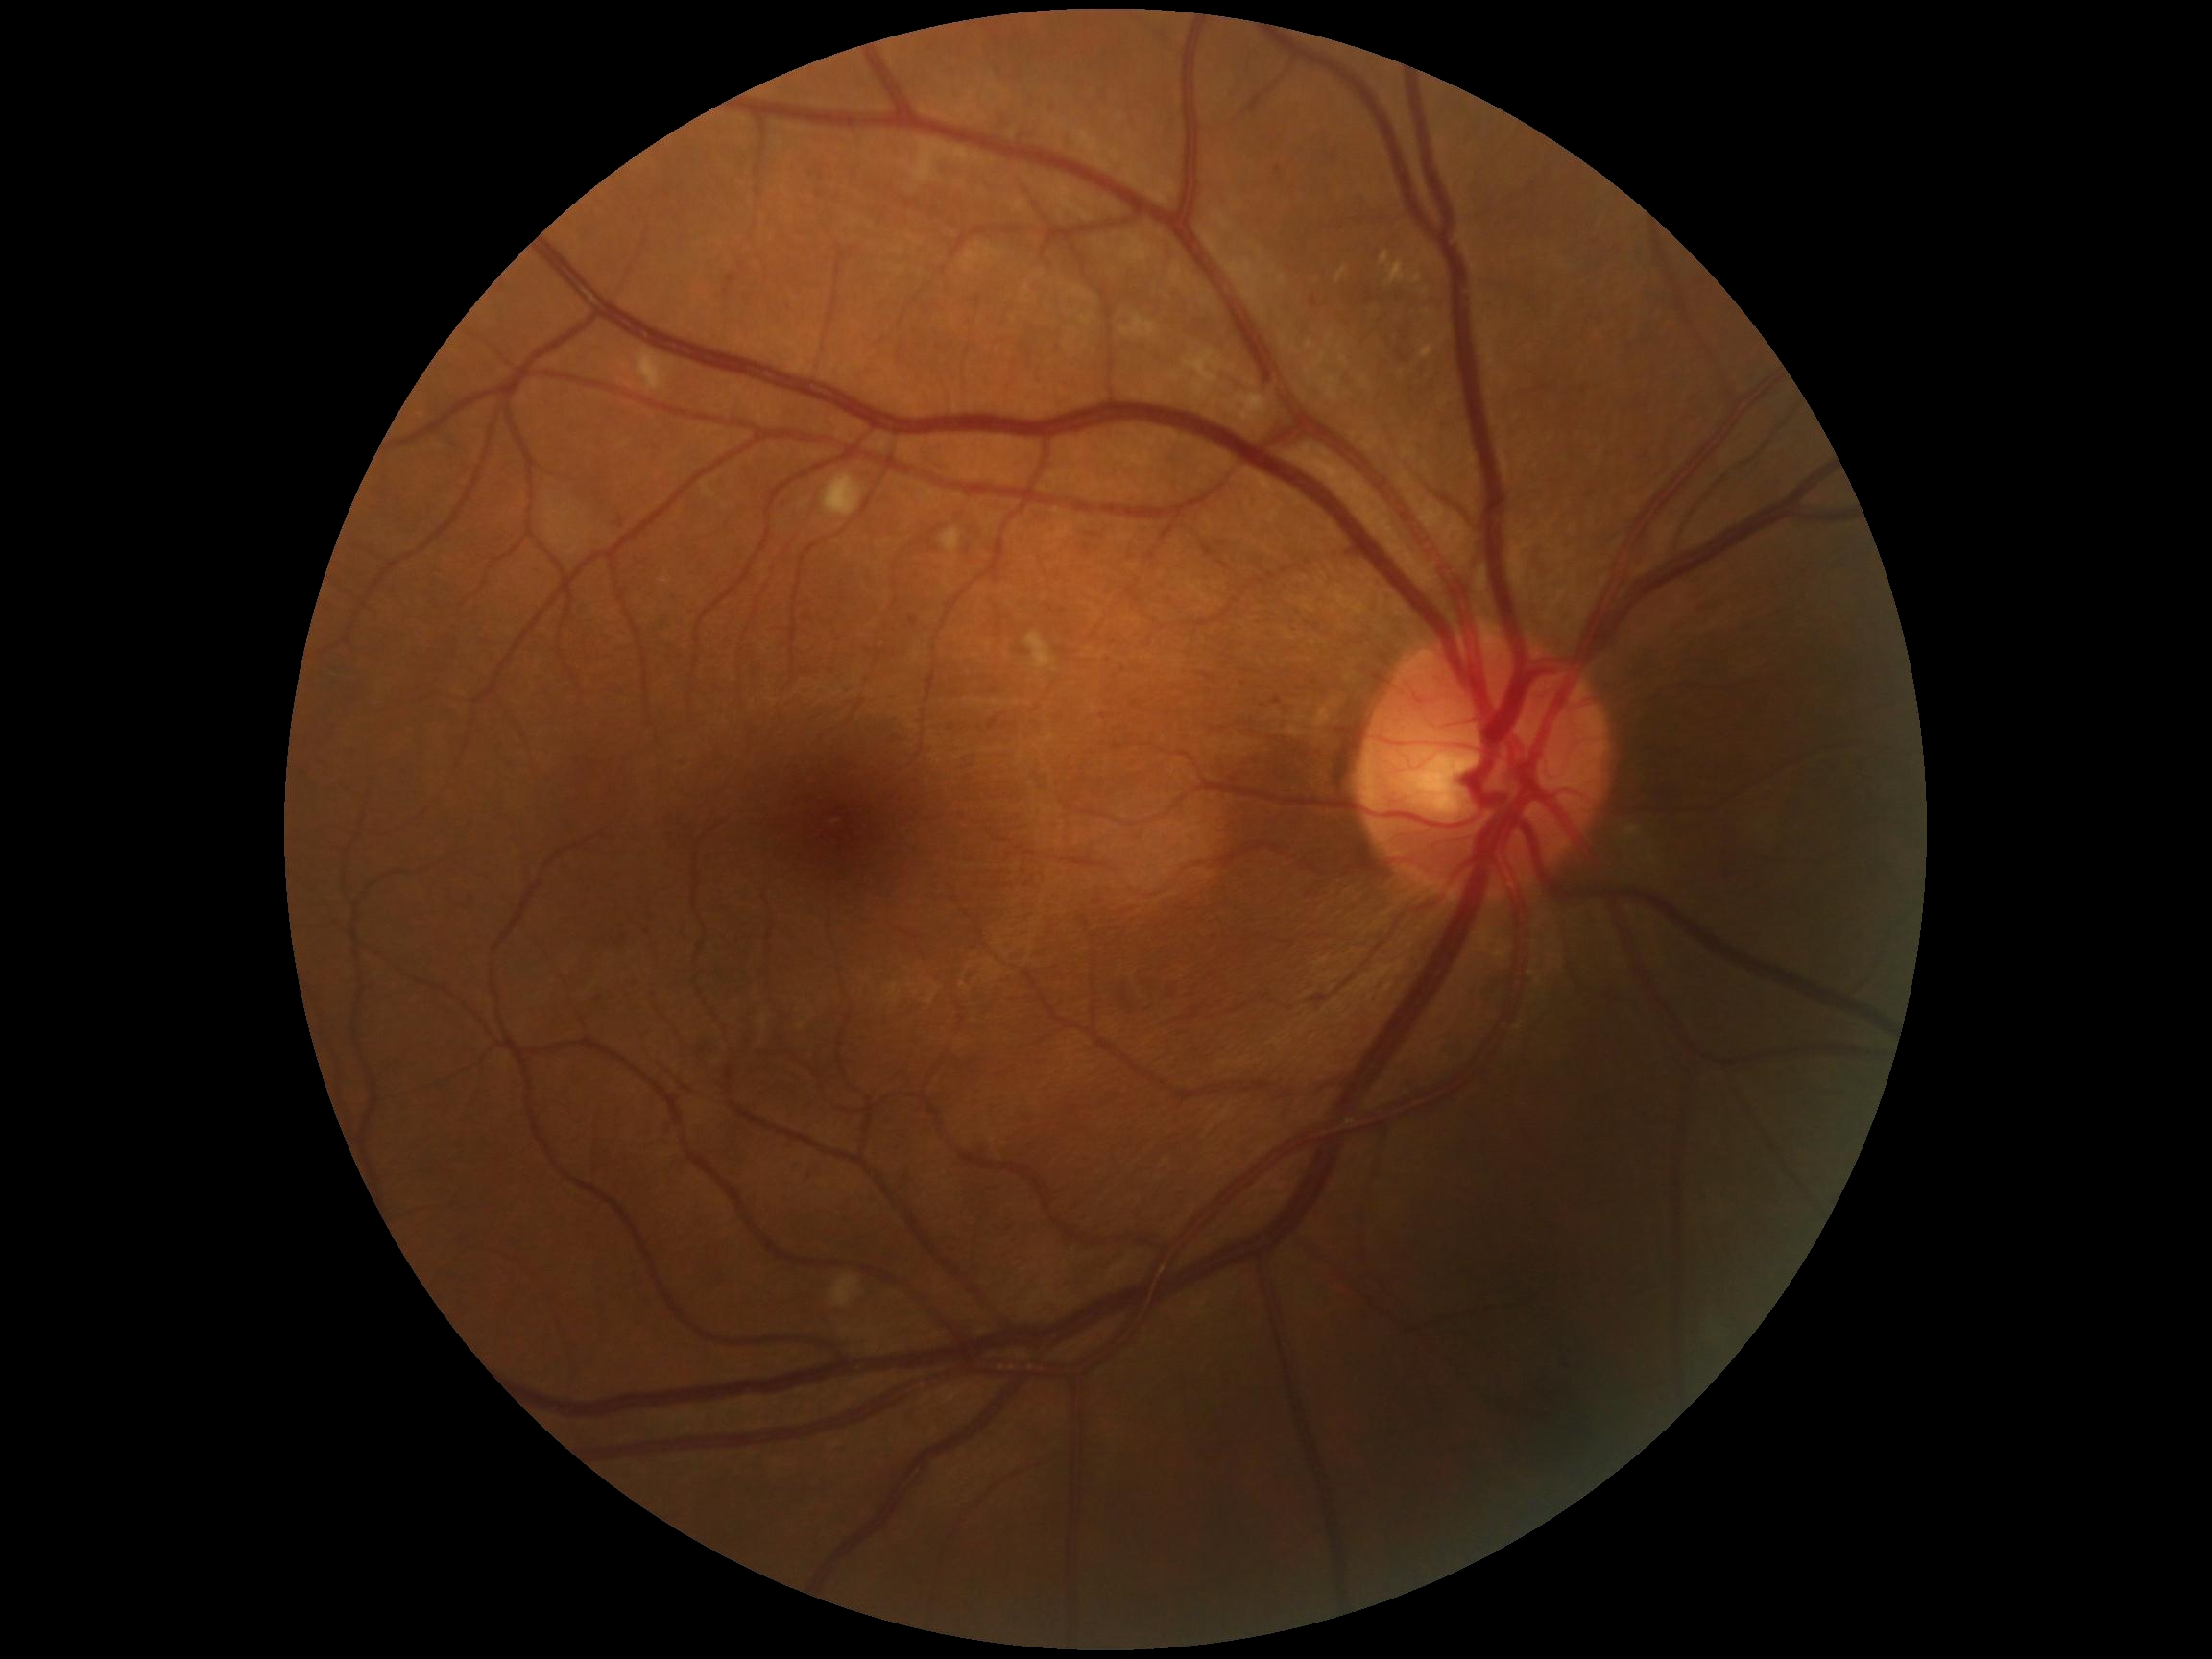
DR class: non-proliferative diabetic retinopathy.
DR grade: 2 (moderate NPDR).